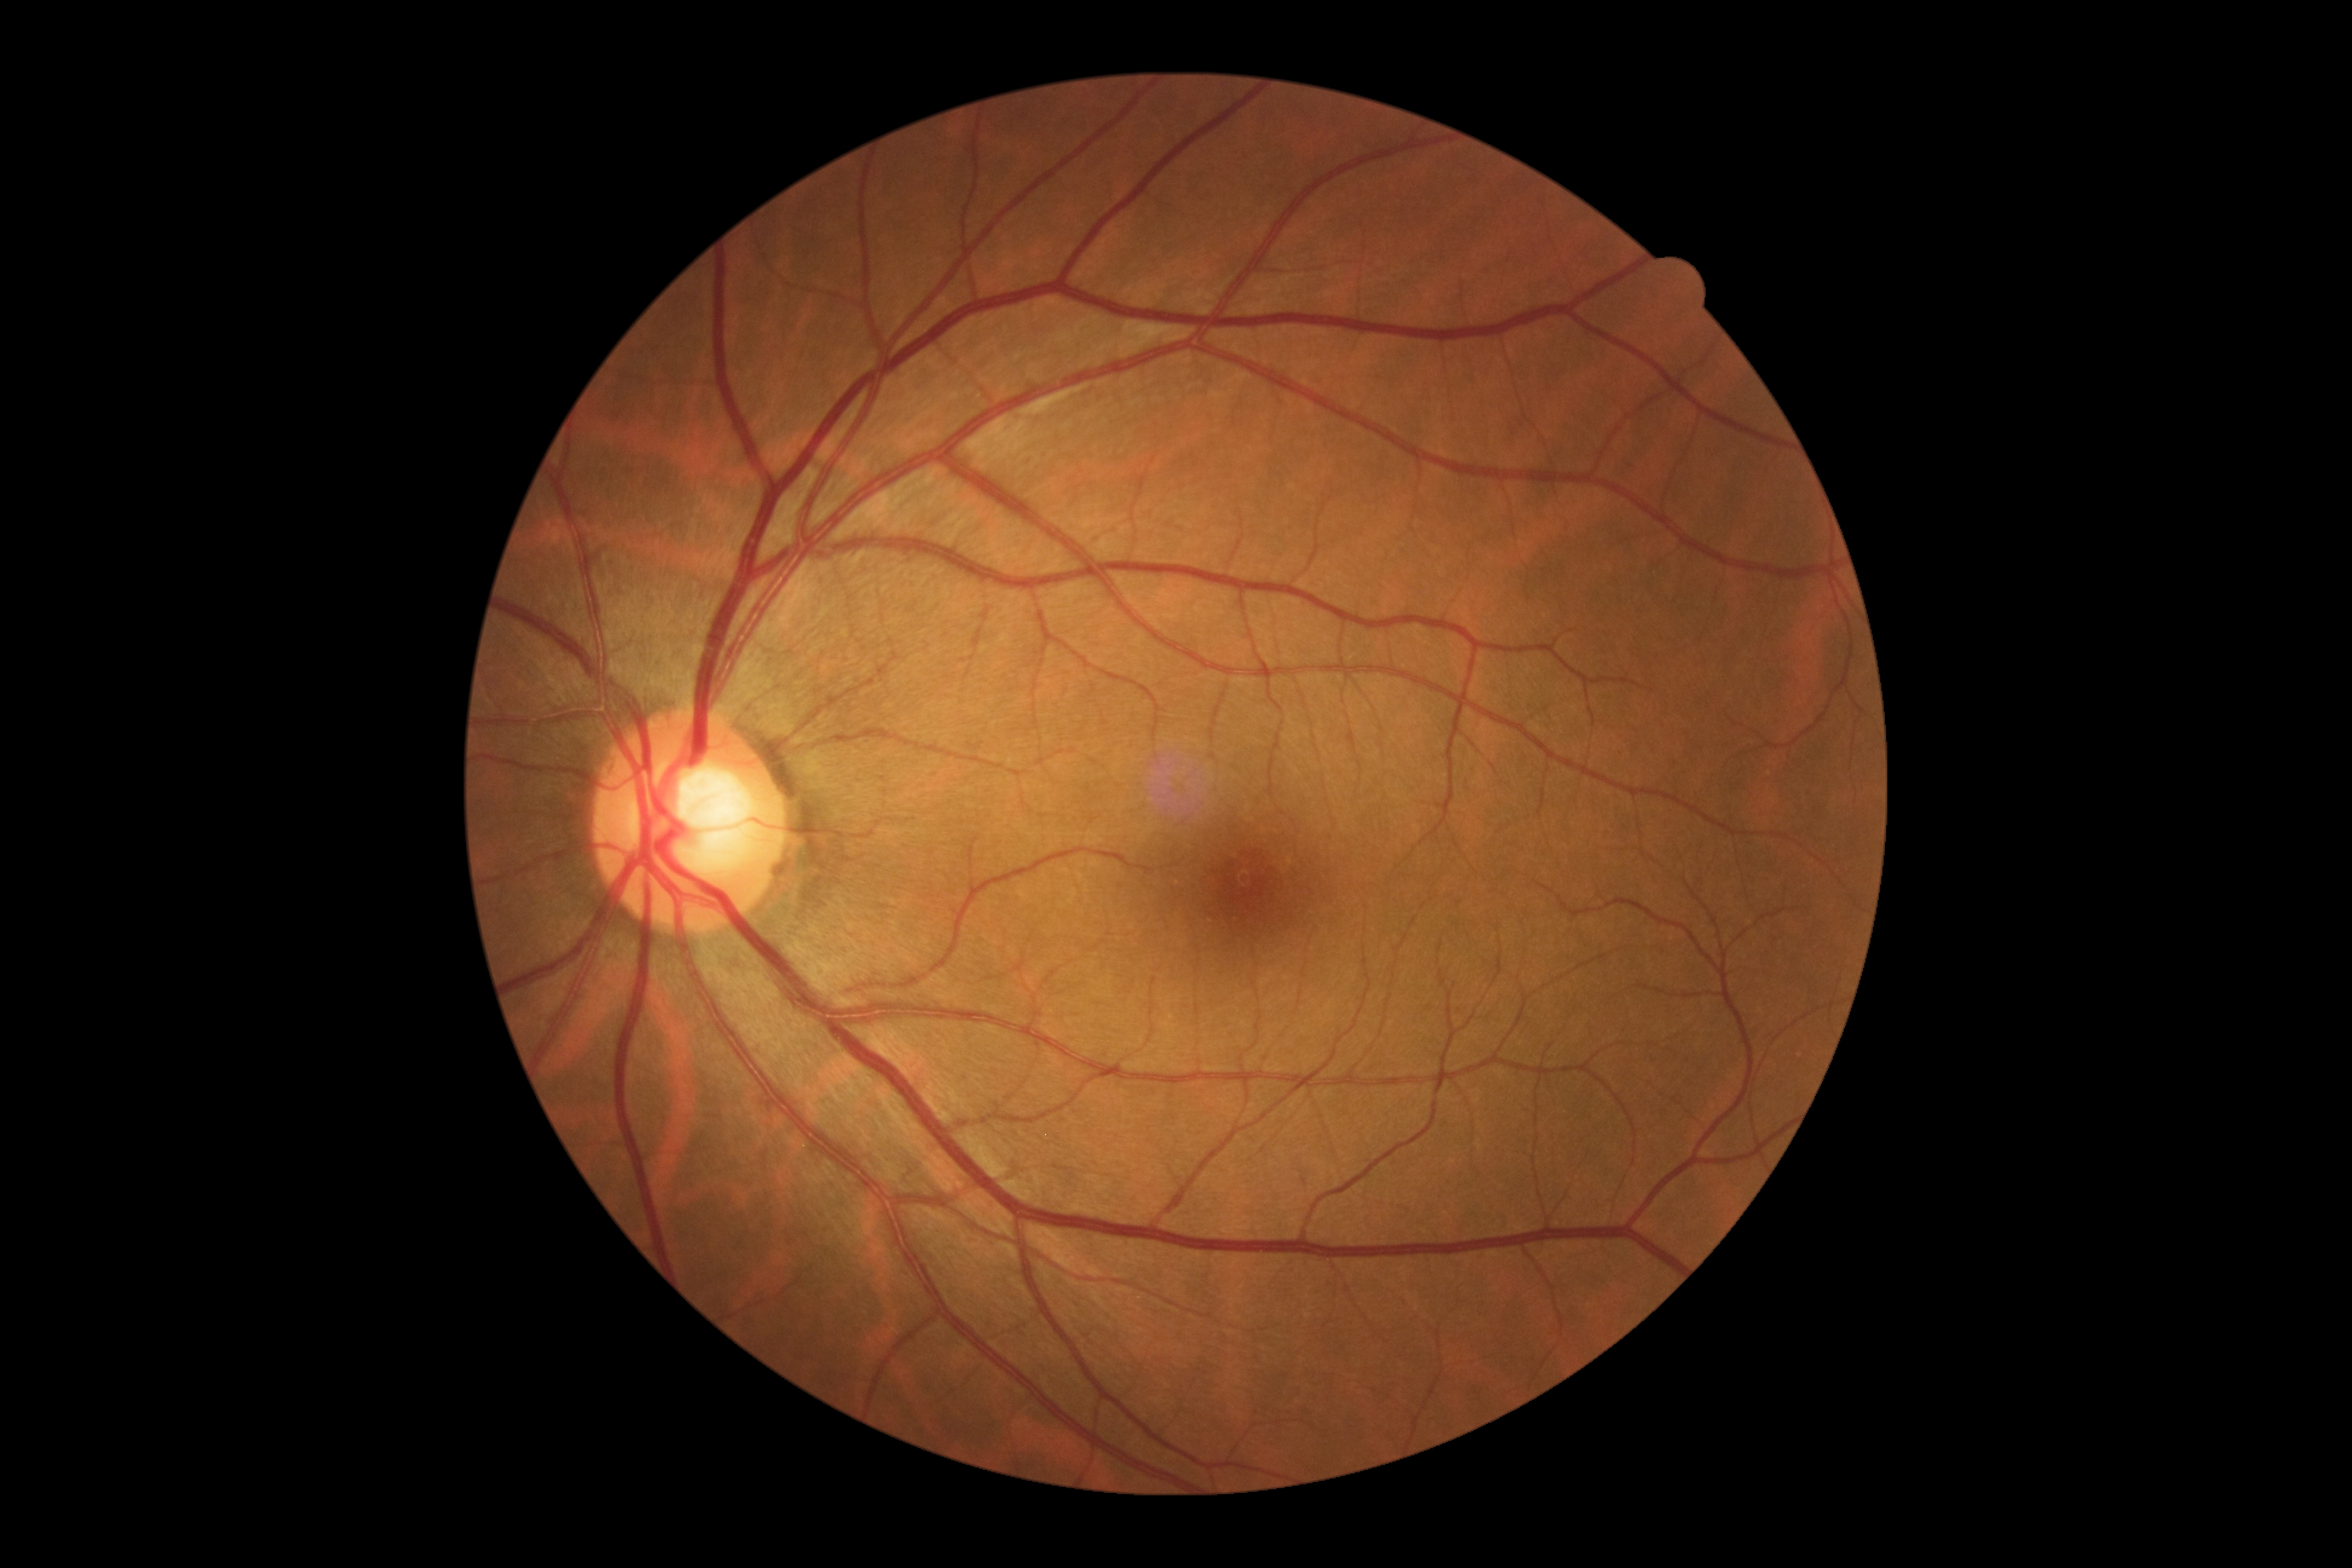
diabetic retinopathy: grade 0.